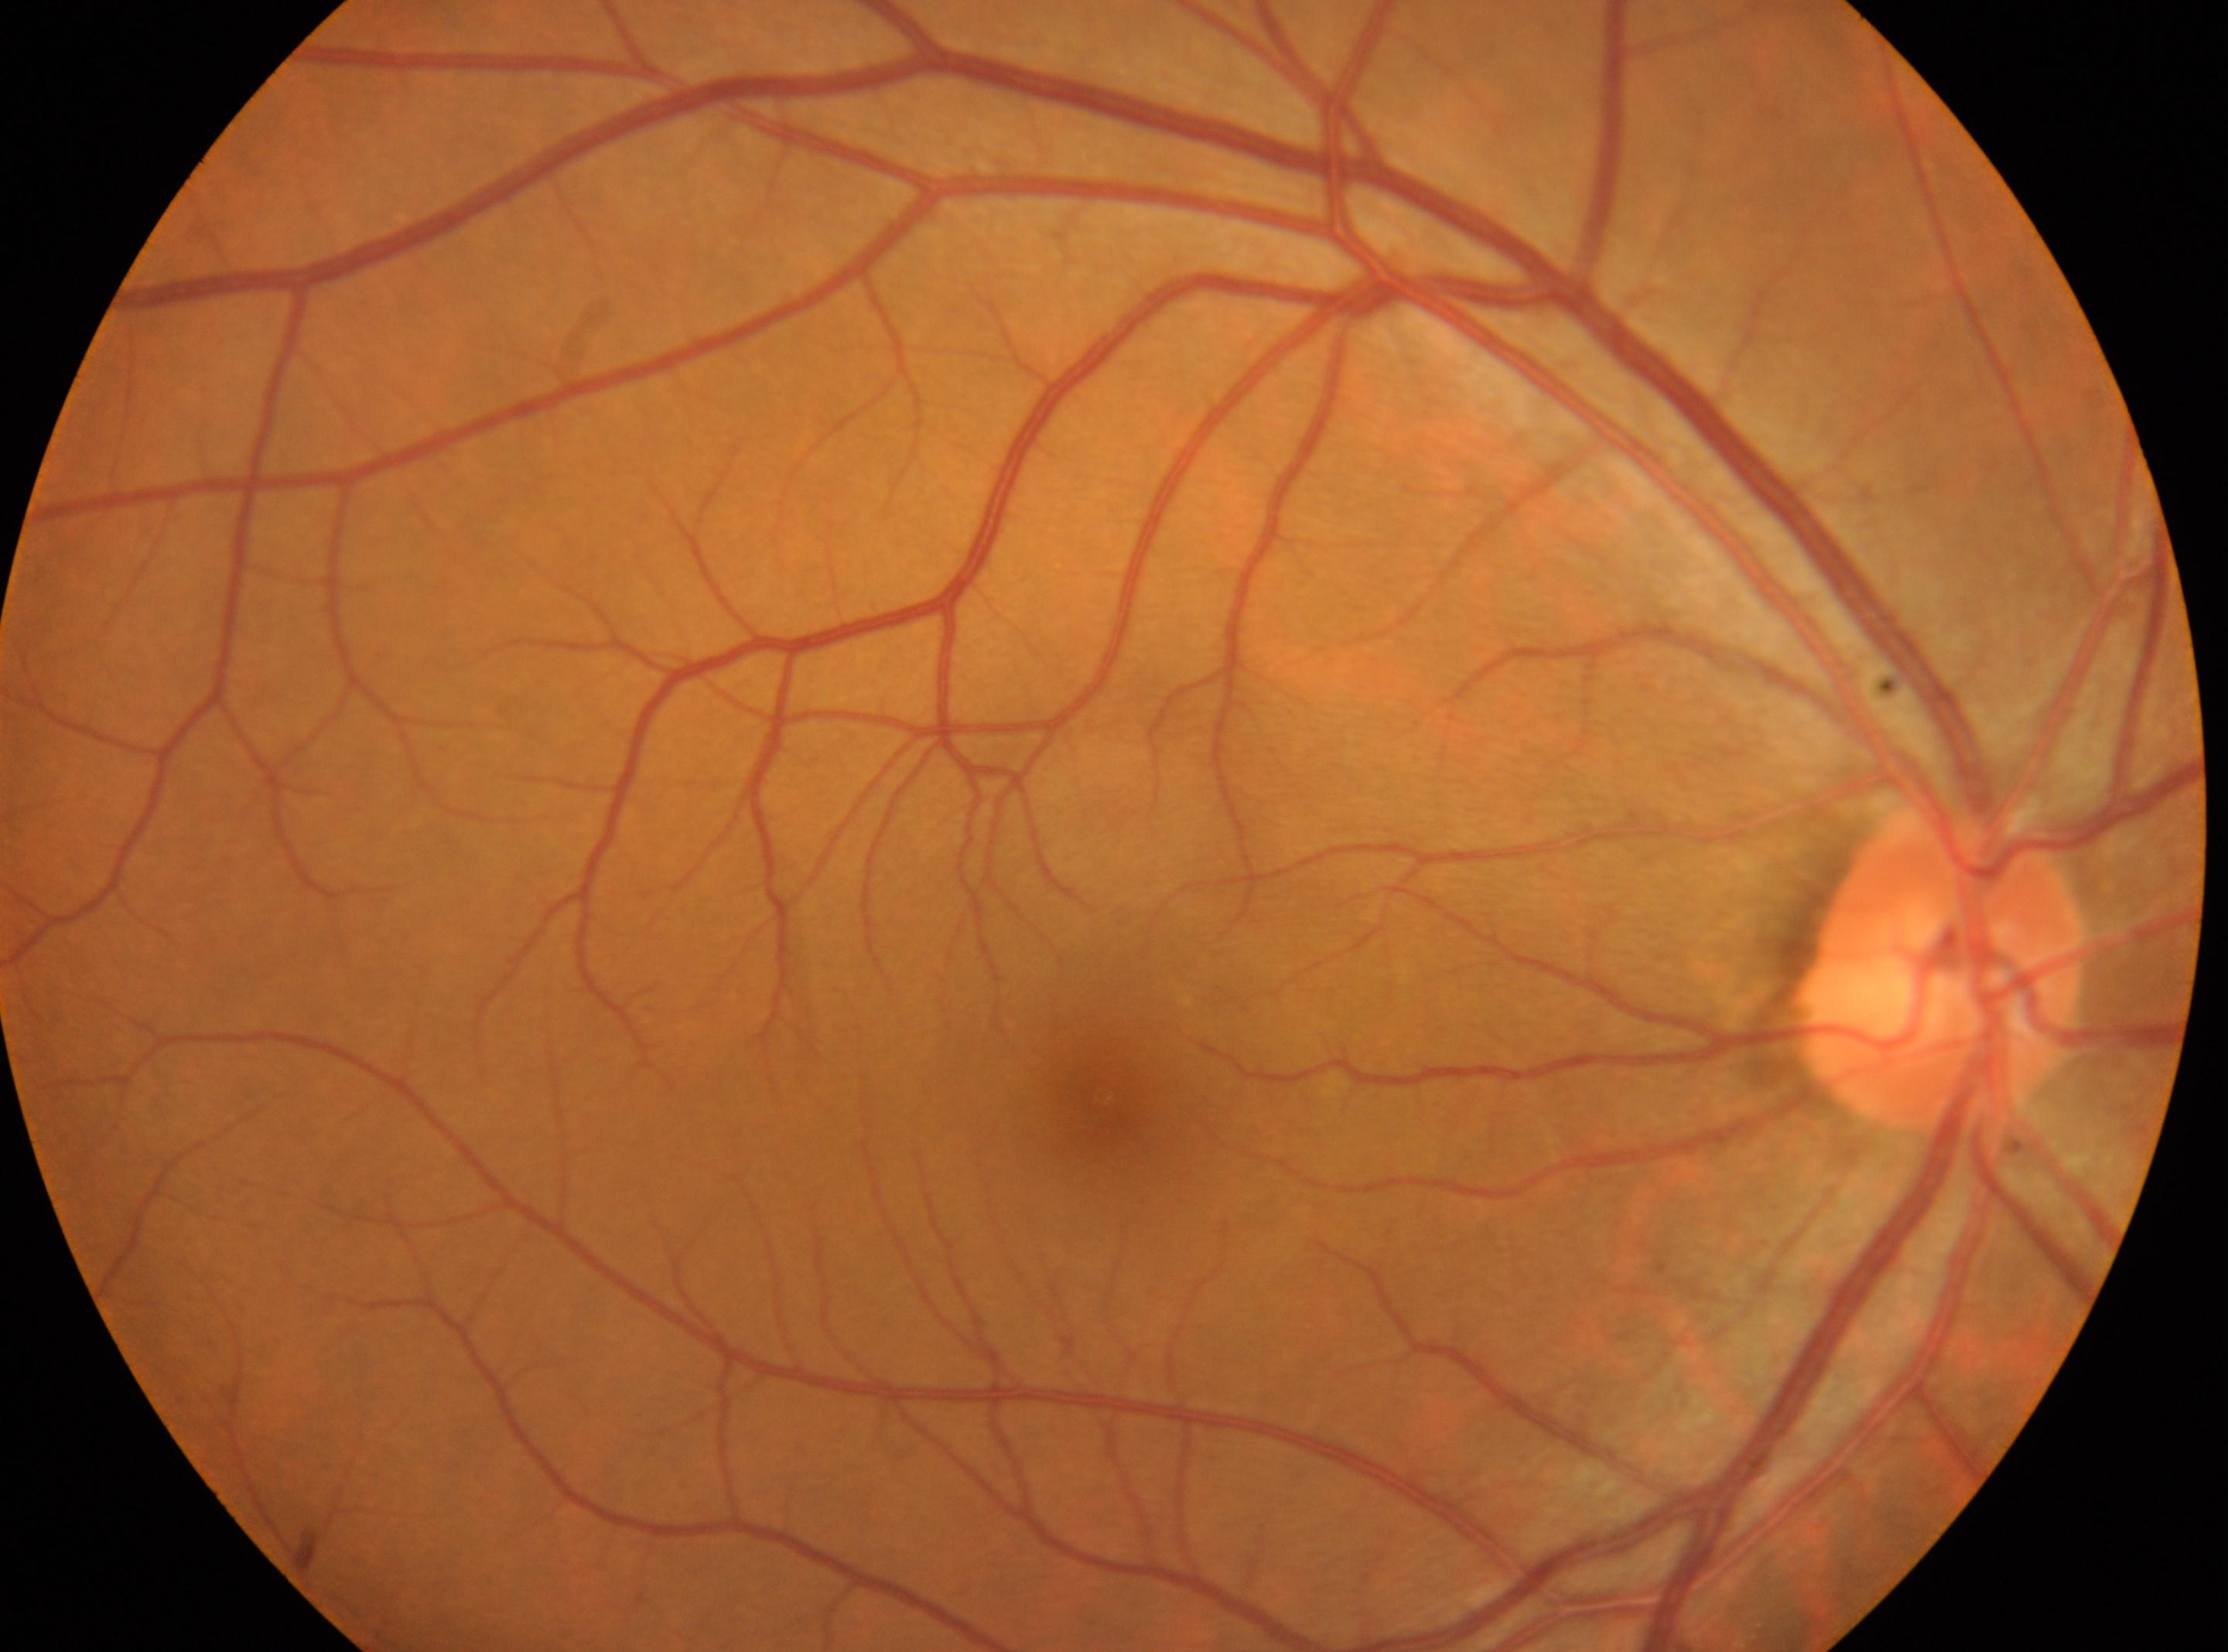

fovea centralis: (1105,1095); No DR findings; optic disc center: (1939,974); oculus dexter; DR severity: no apparent retinopathy (grade 0).